Acquired with a Remidio Fundus on Phone (FOP) camera.
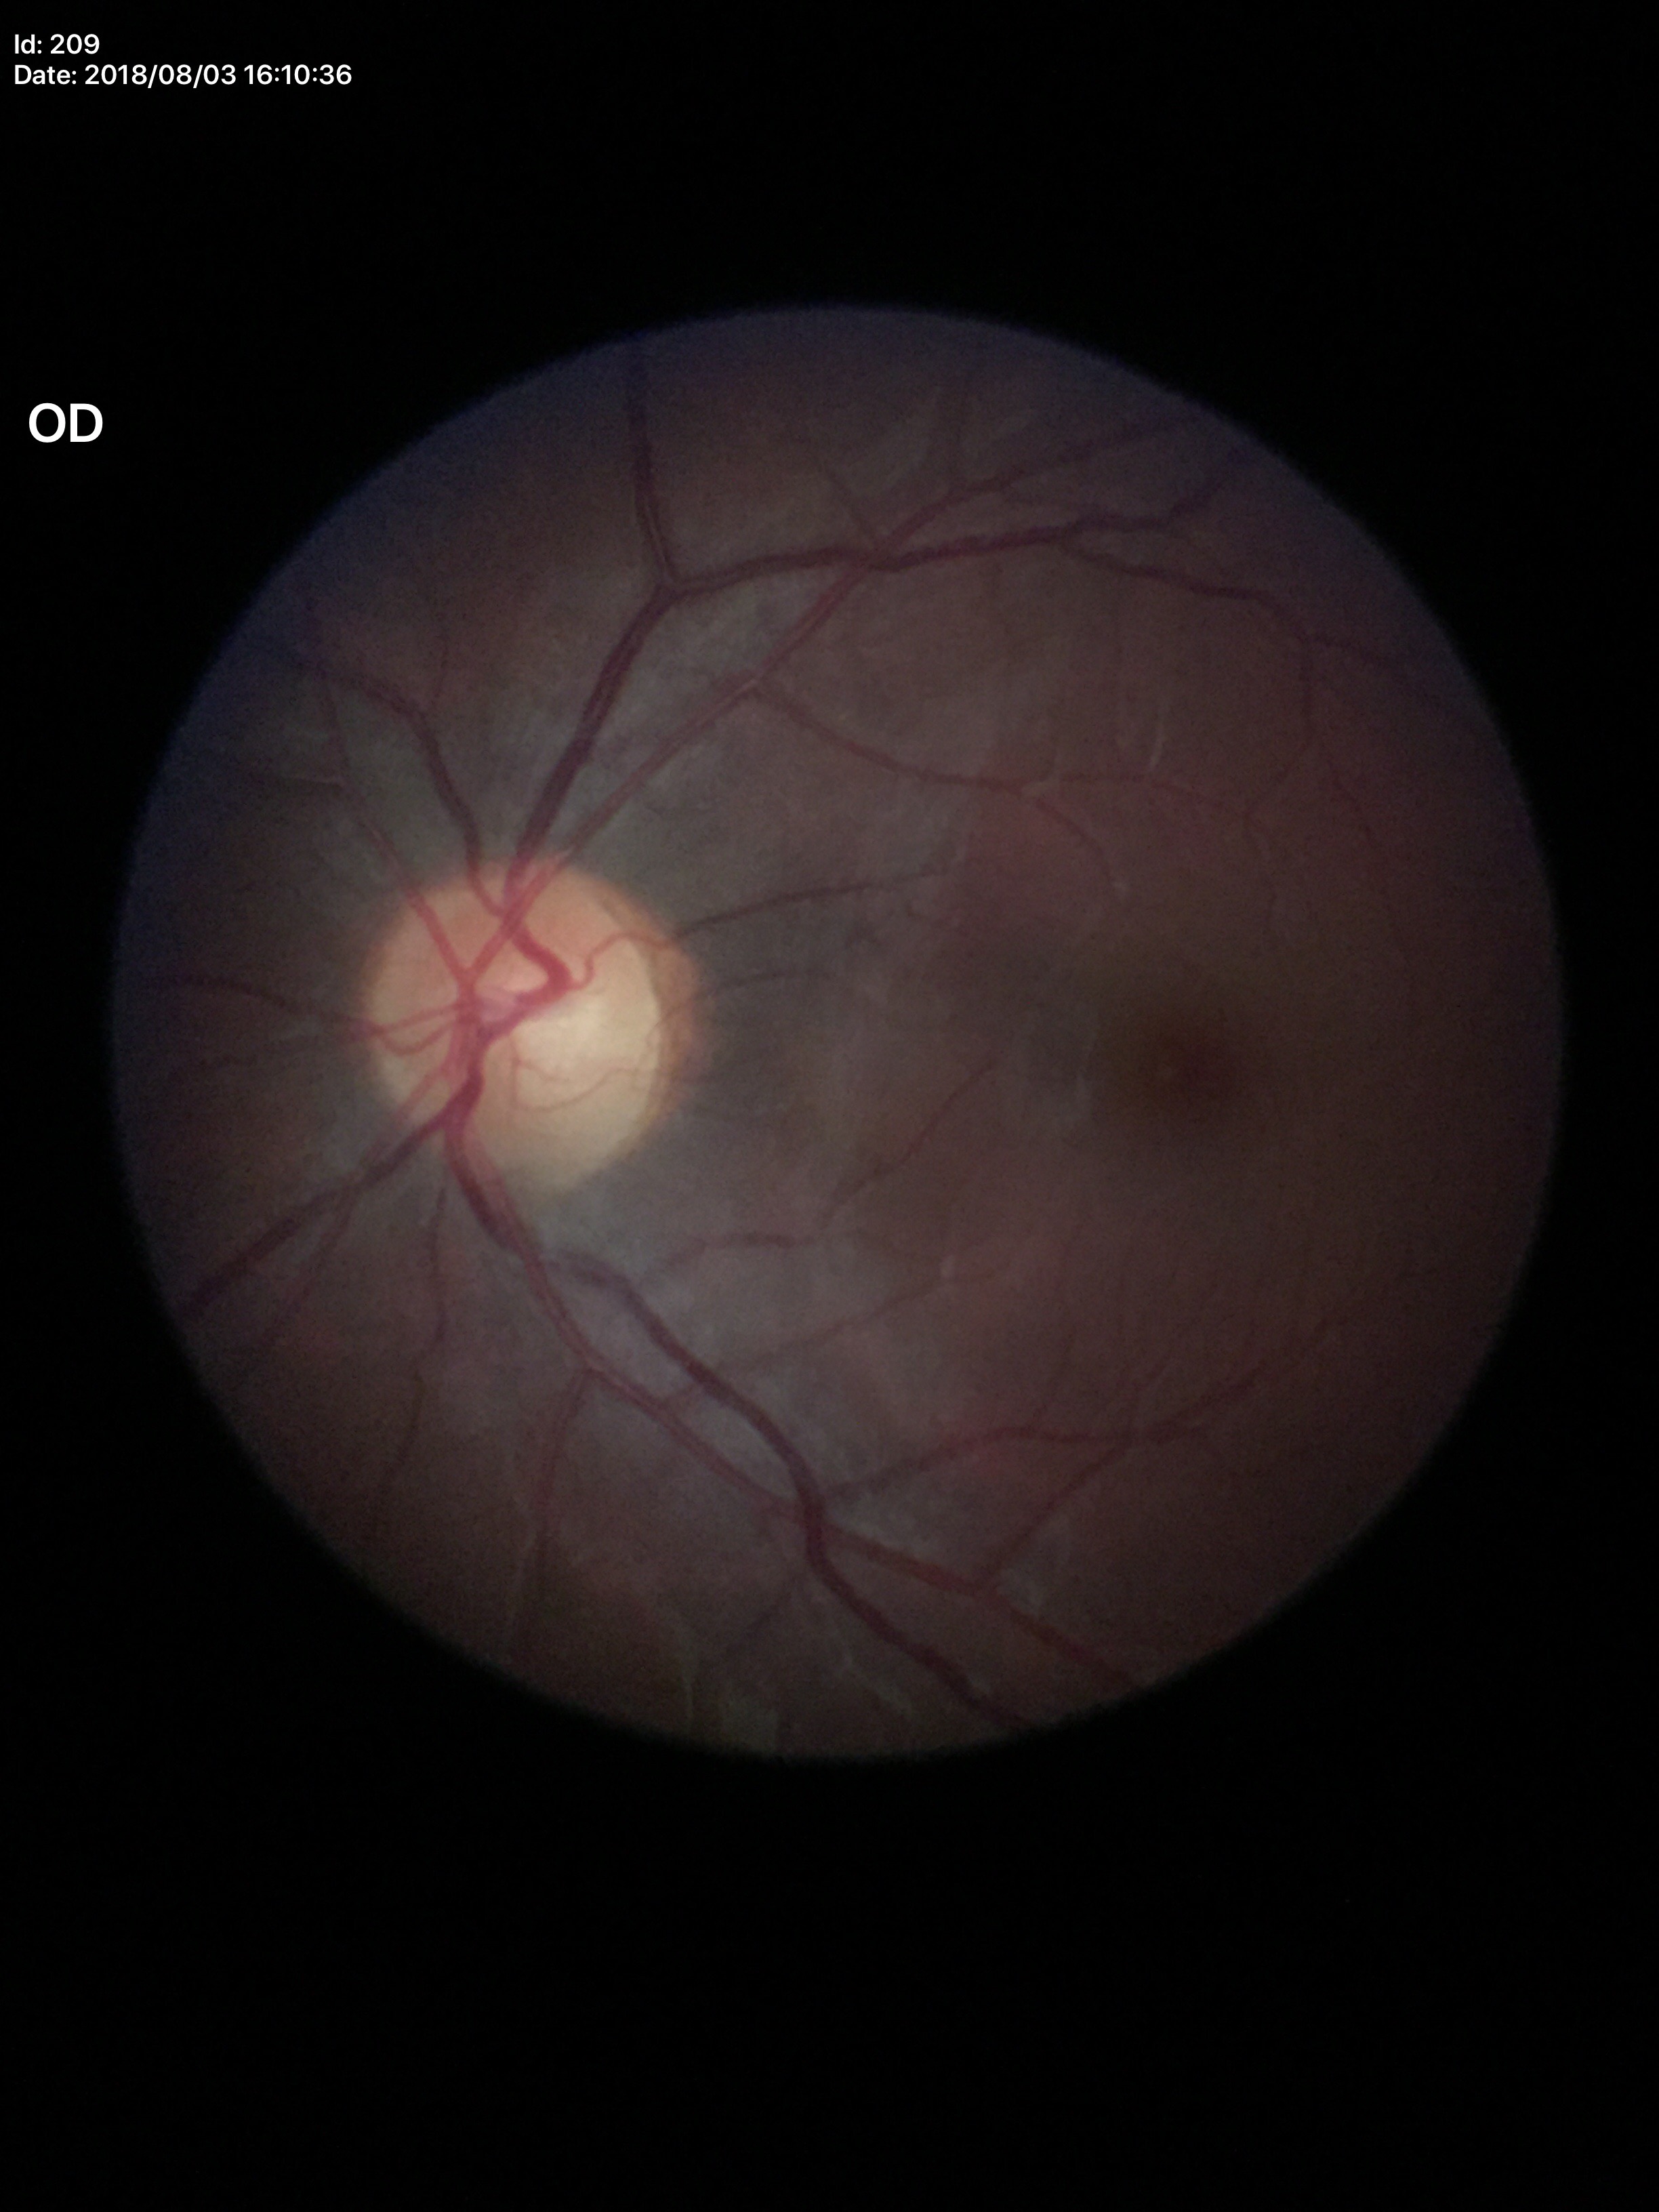

glaucoma_decision: no suspicious findings
vcdr: 0.52
hcdr: 0.55